45° field of view
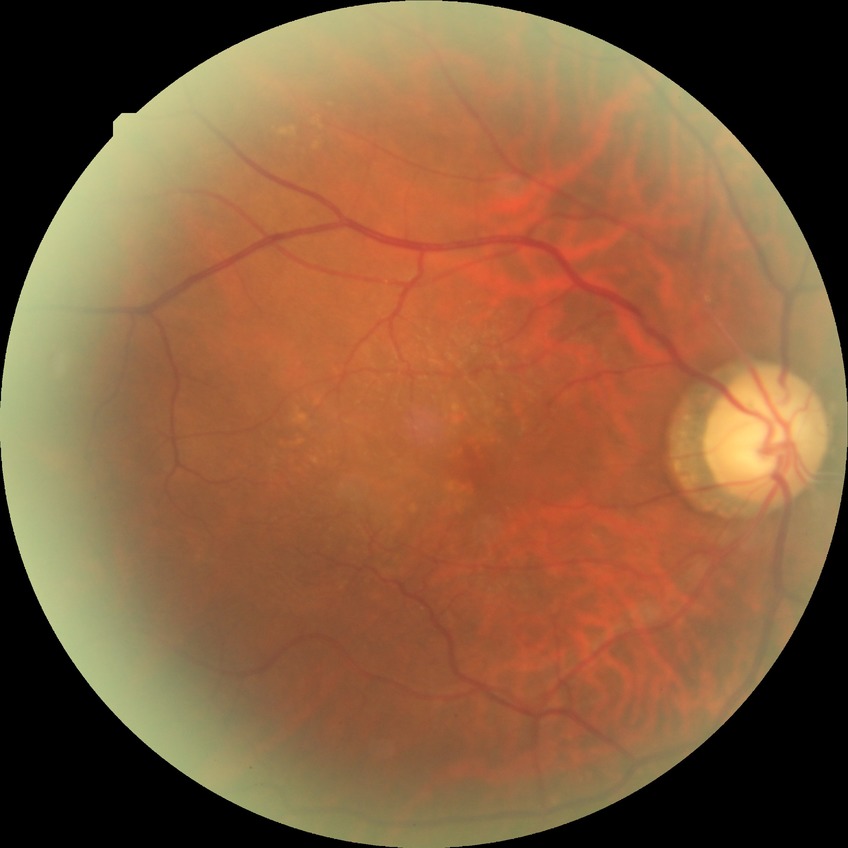
Davis grading: no diabetic retinopathy.